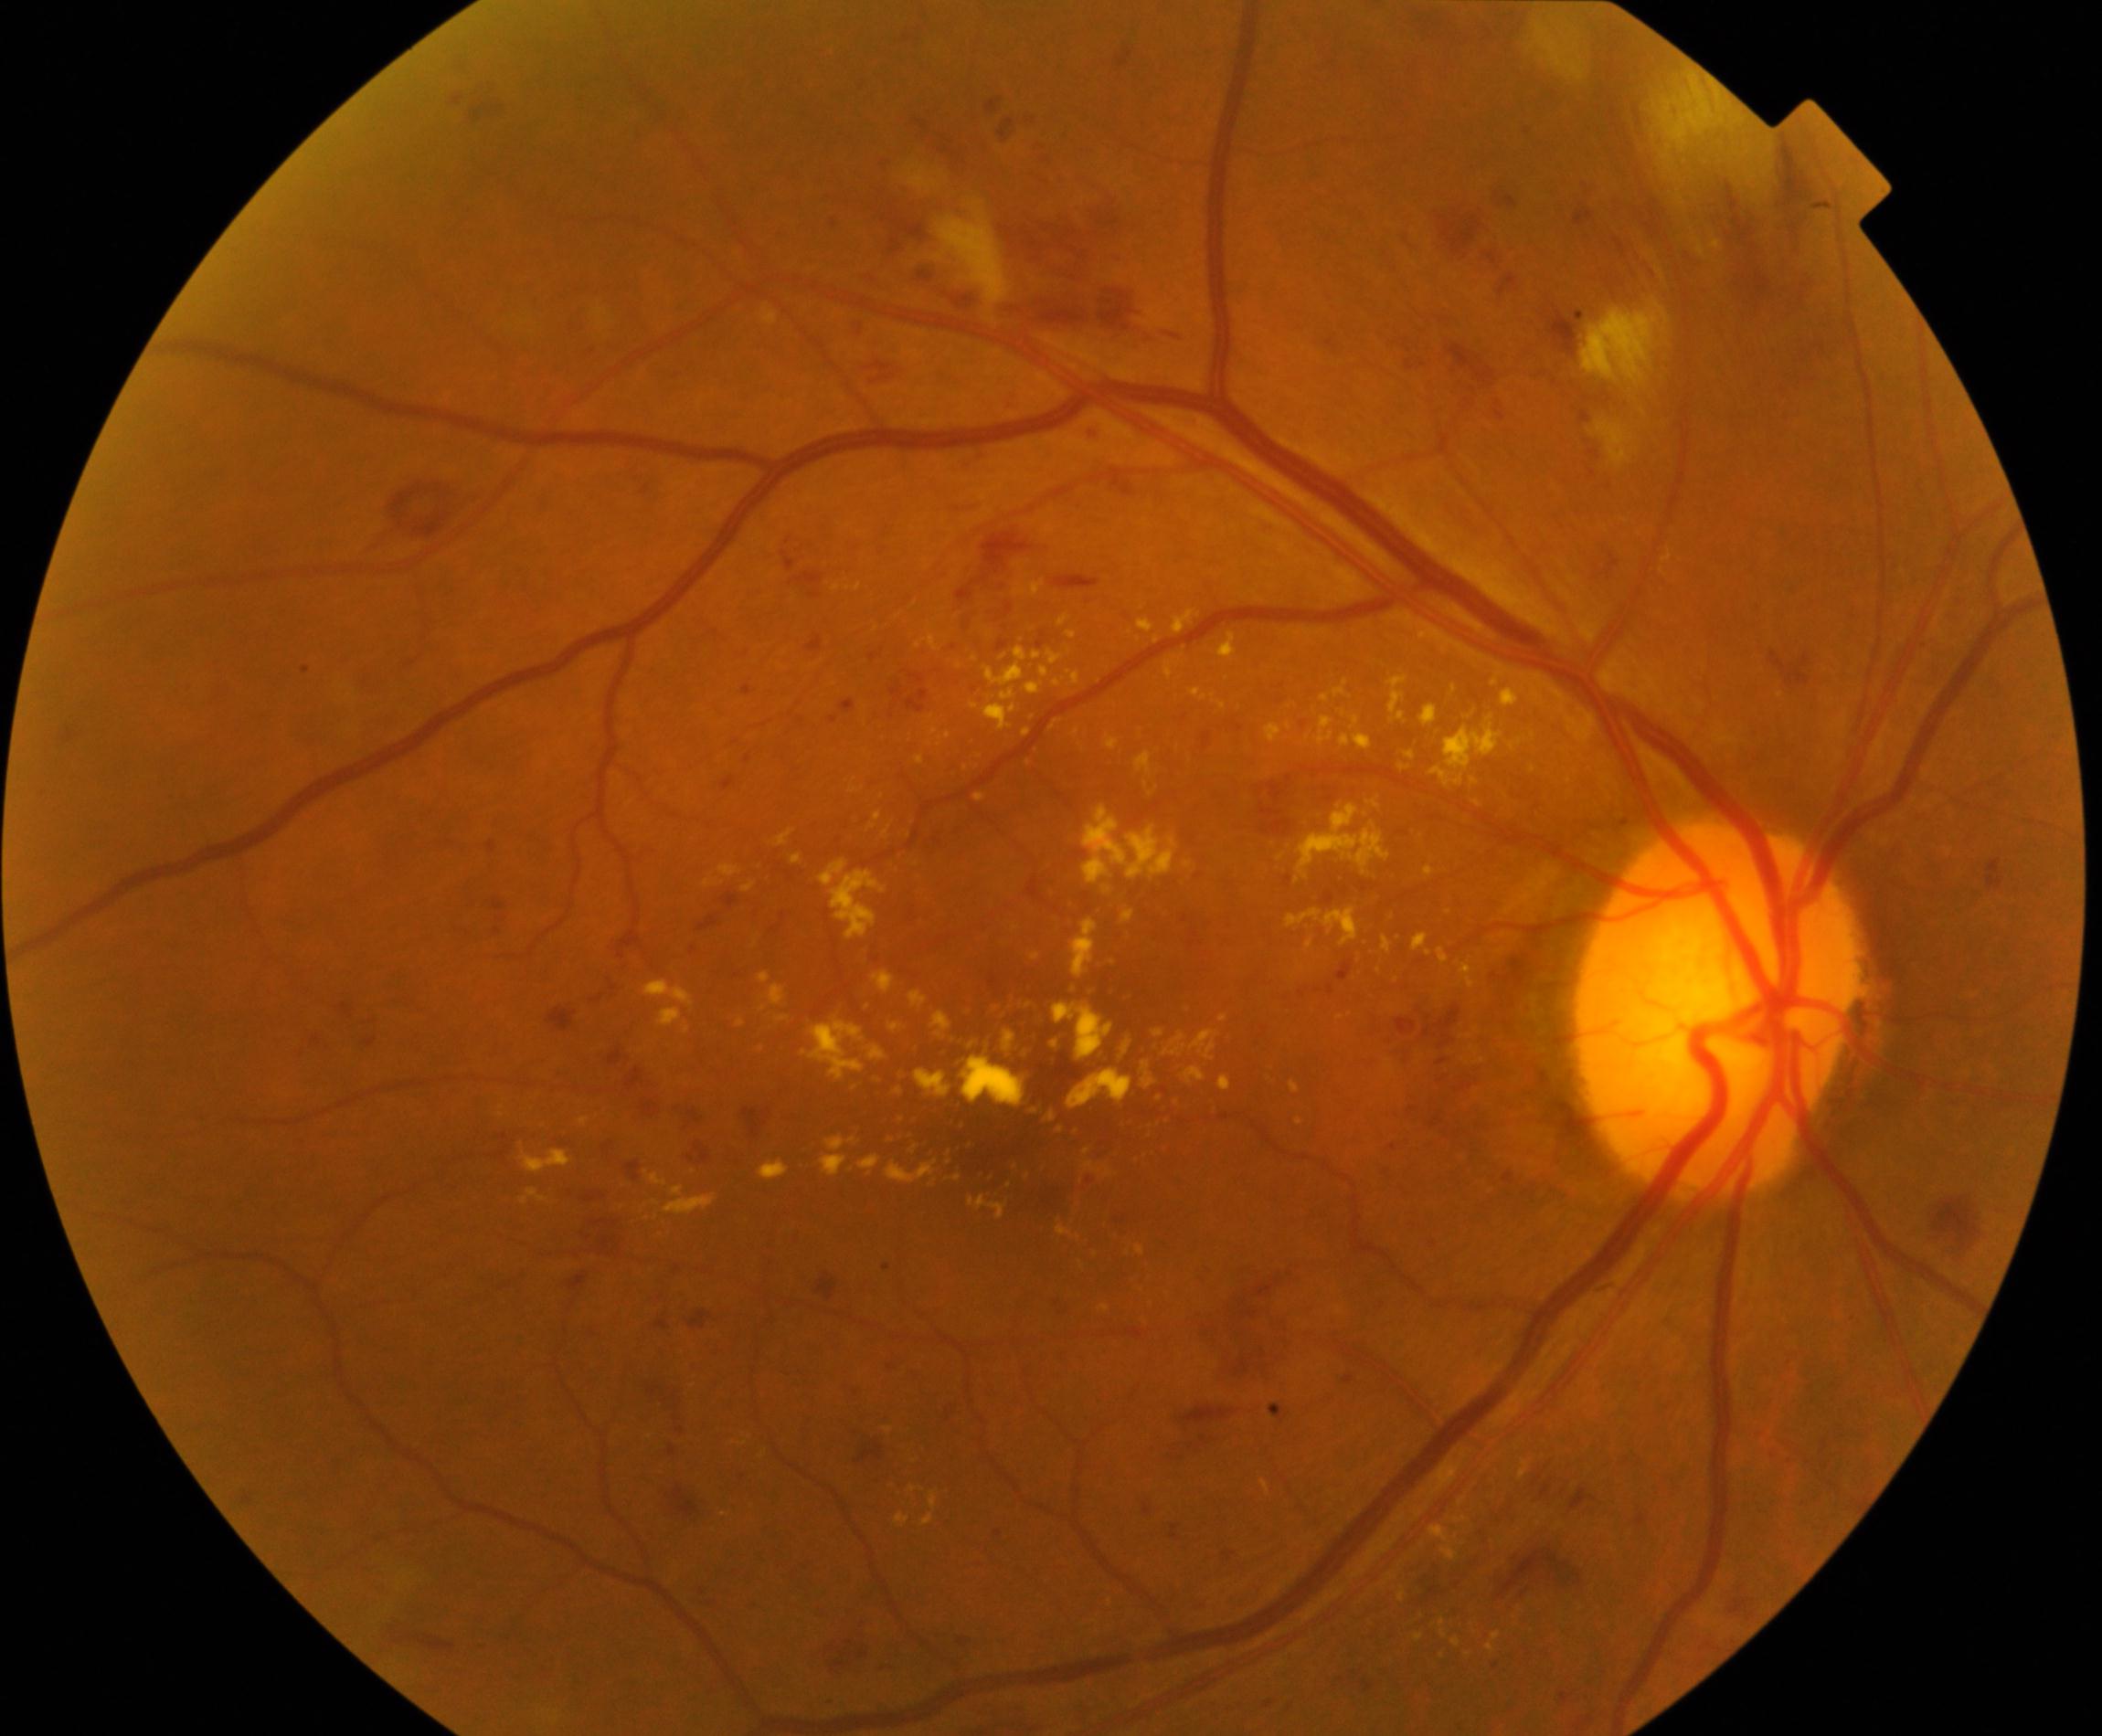 There is evidence of moderate non-proliferative diabetic retinopathy.